Diabetic retinopathy graded by the modified Davis classification
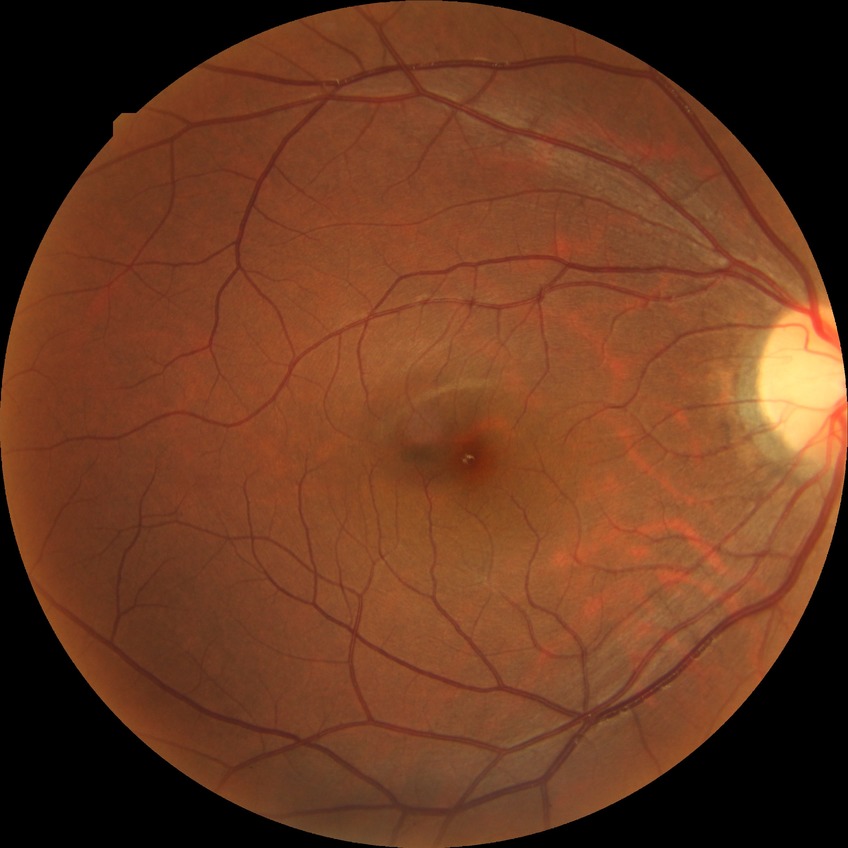
retinopathy grade = no diabetic retinopathy